Retinal fundus photograph:
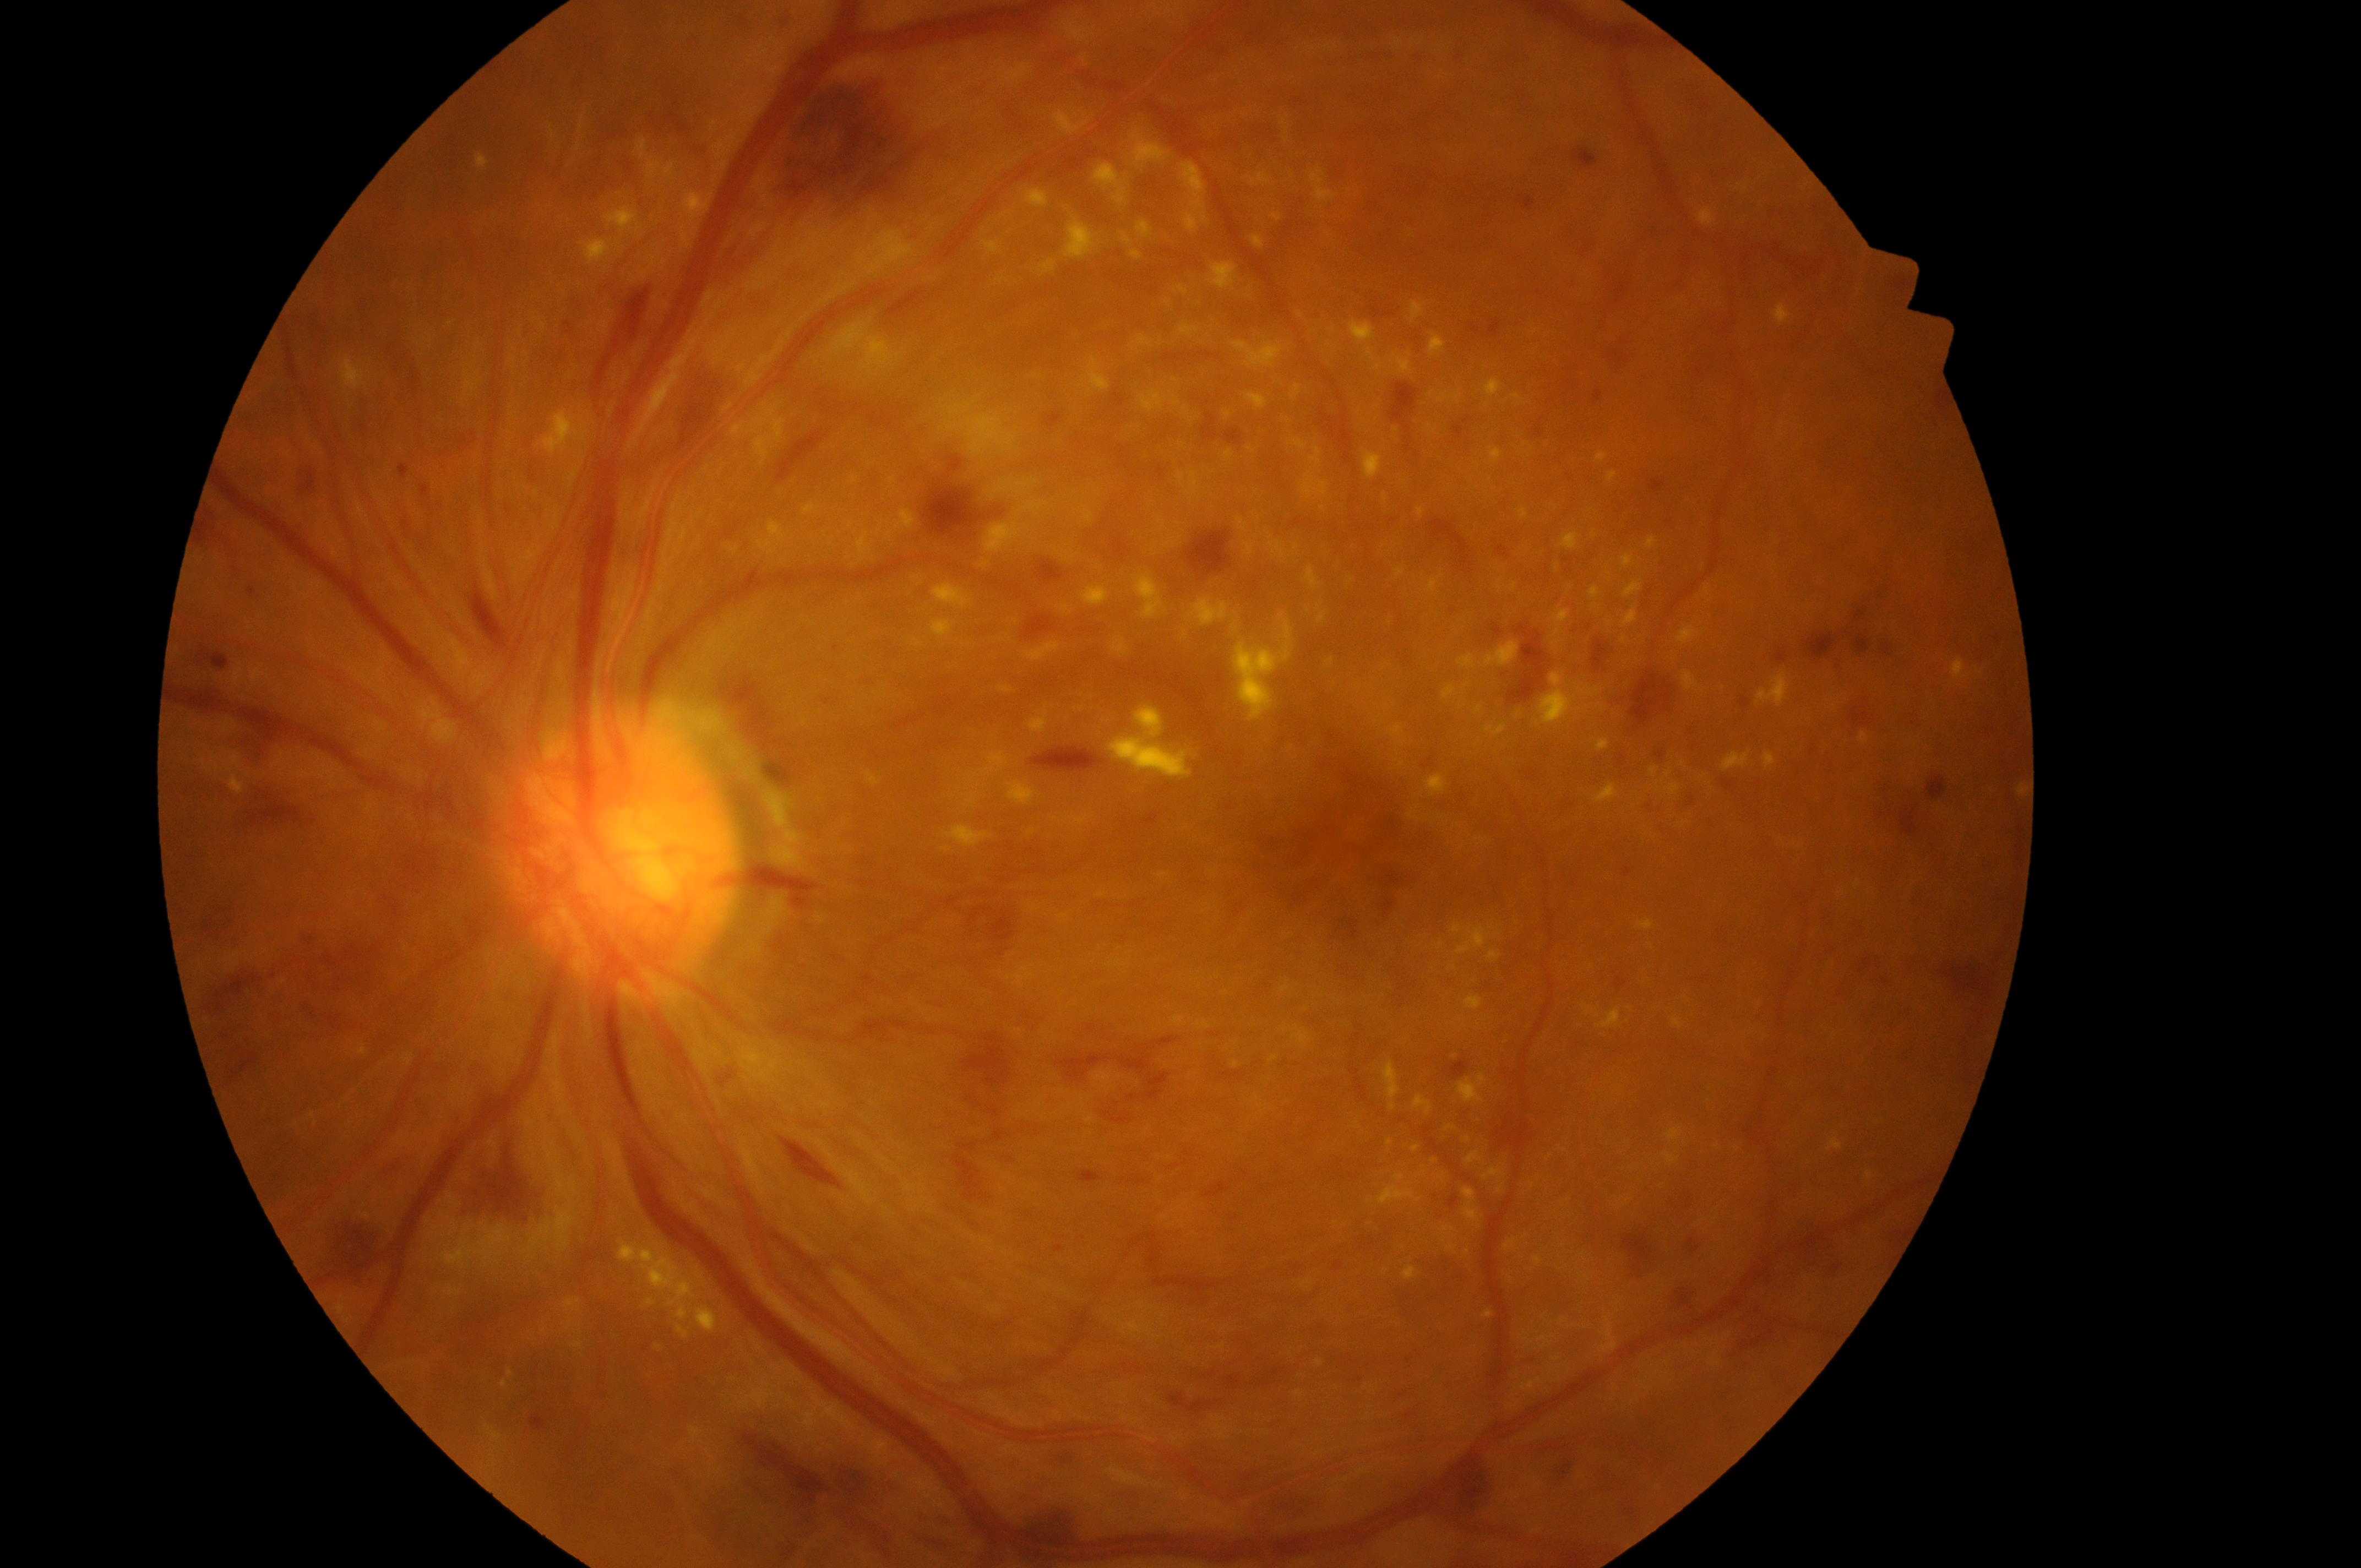
{"dr_grade": "4", "optic_disc": "(x=617, y=858)", "dme_grade": "2", "eye": "OS", "fovea": "(x=1343, y=858)"}